2352 x 1568 pixels
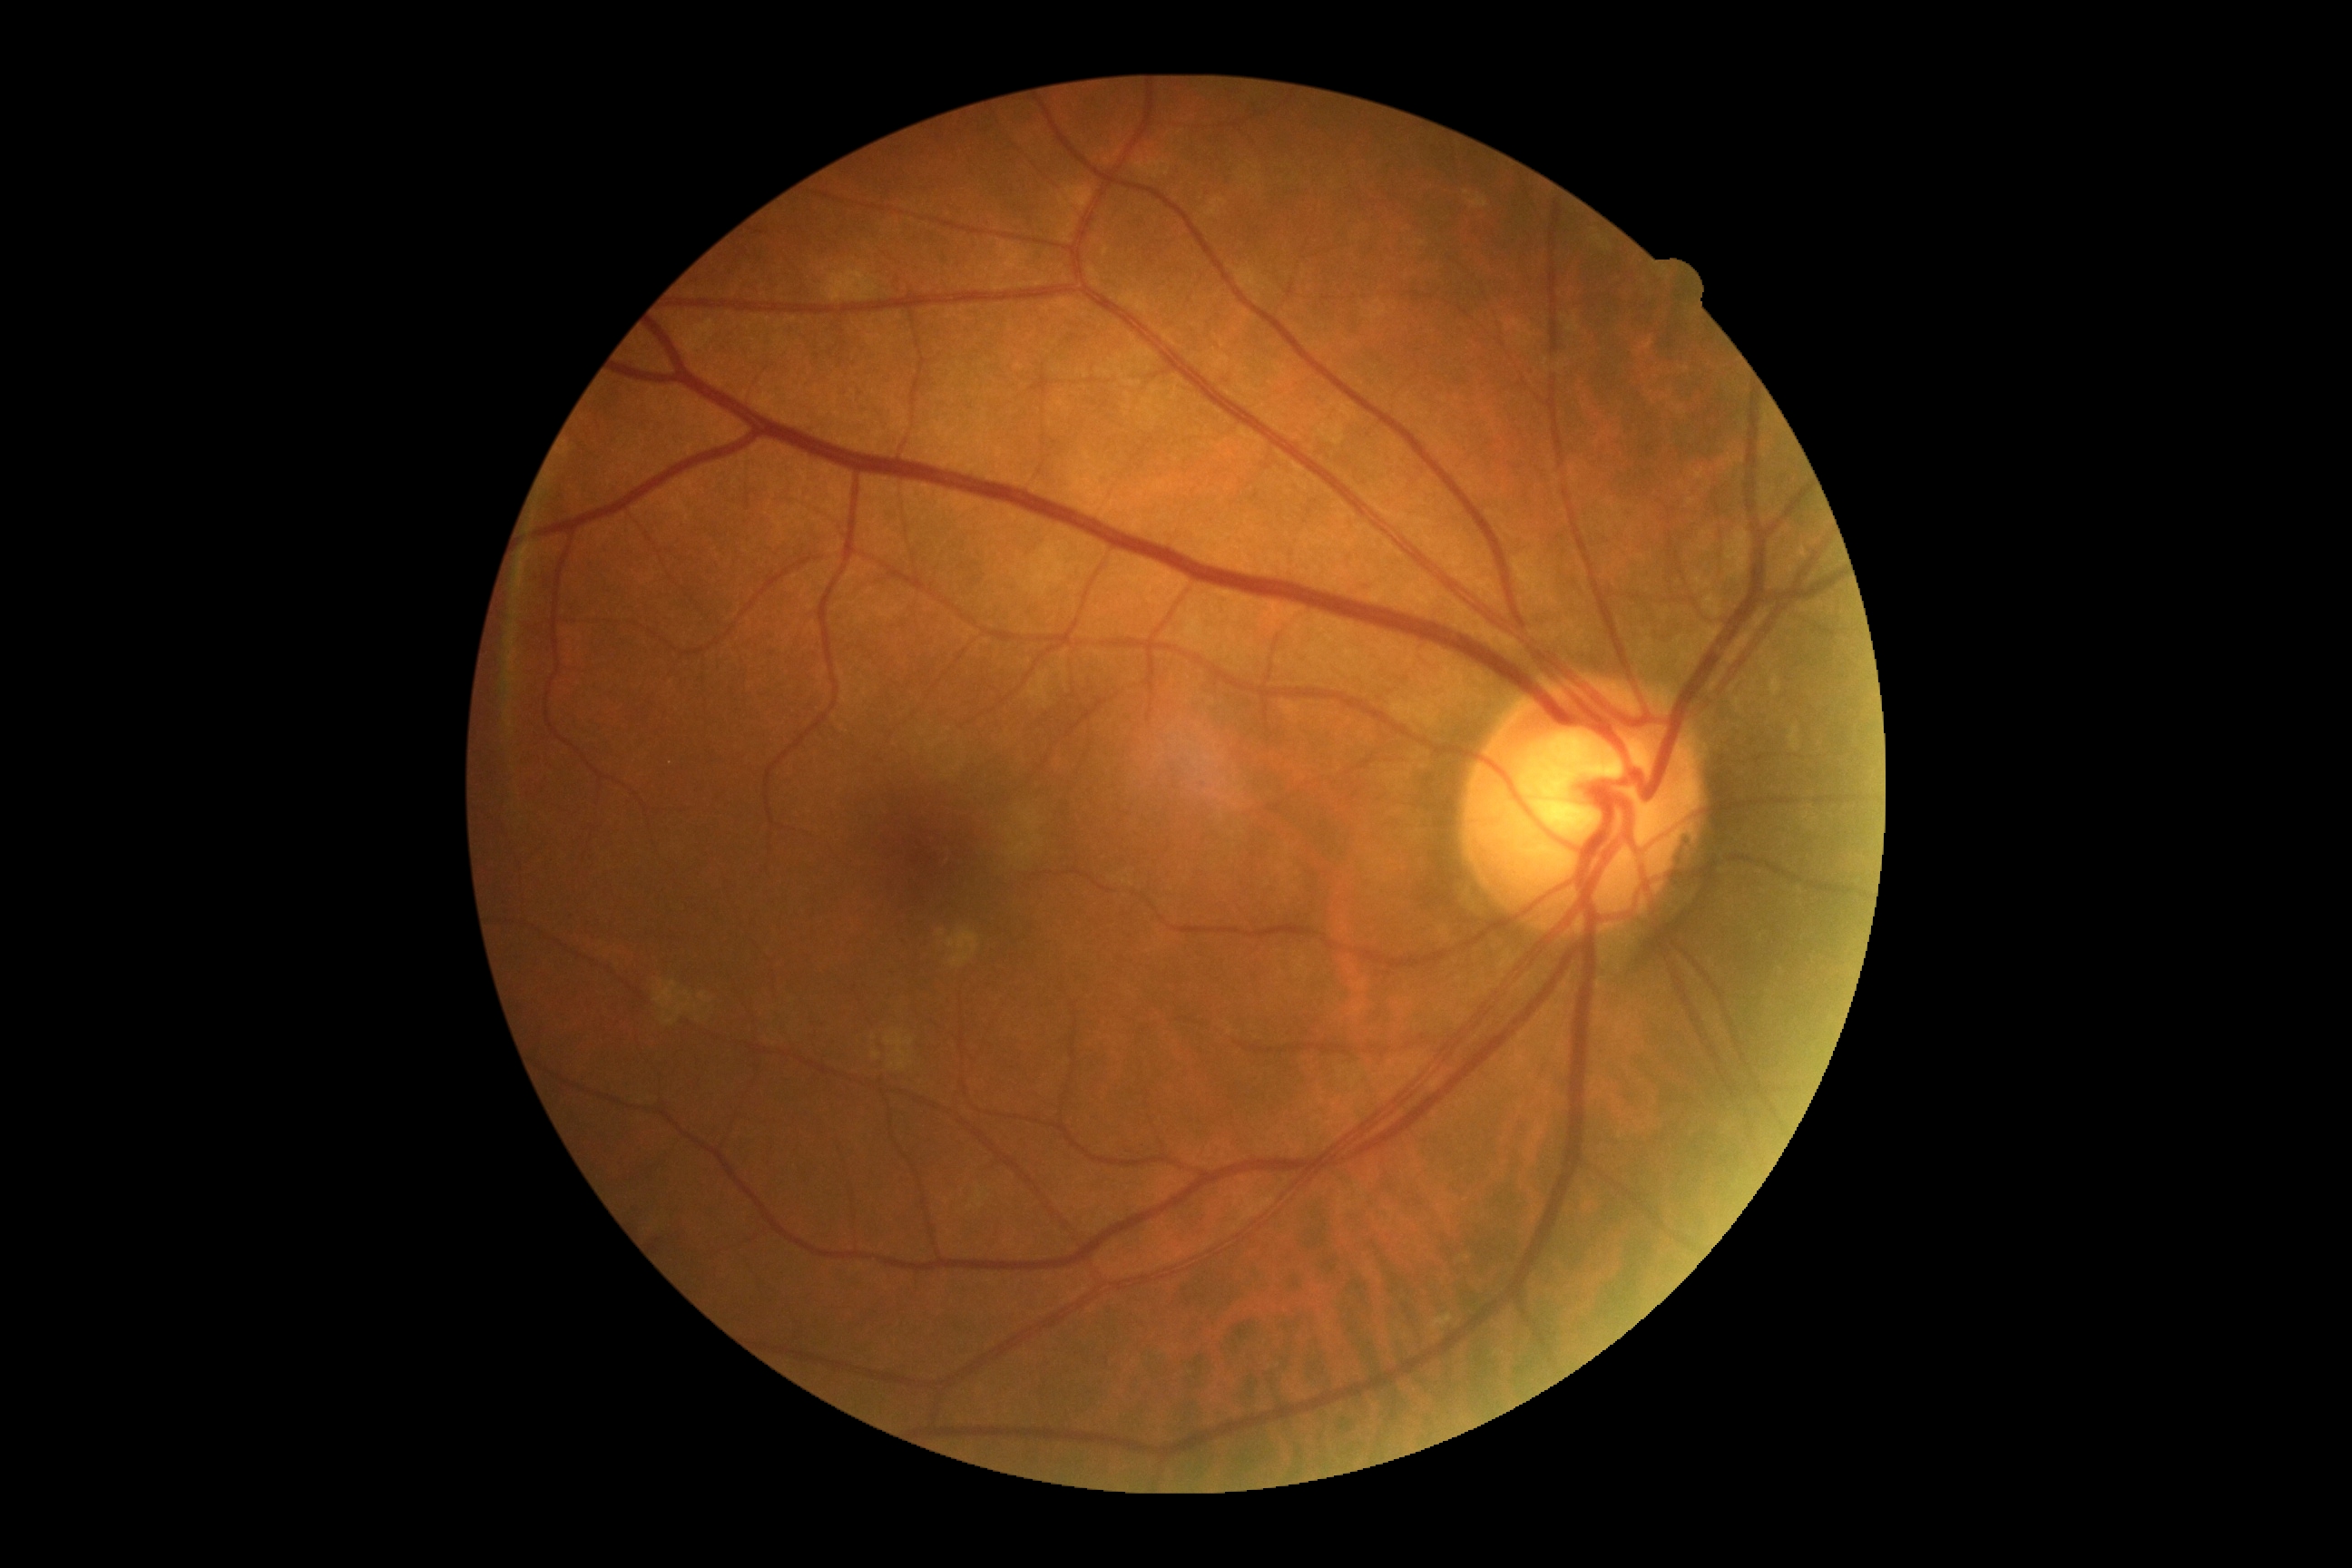
Retinopathy: 0/4.